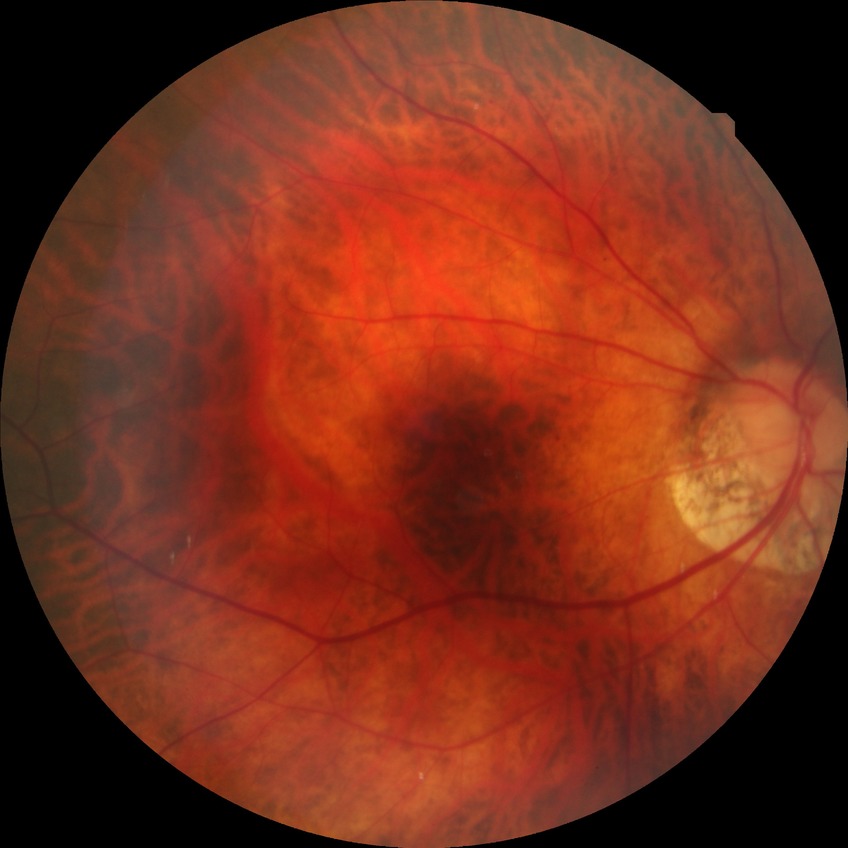 – Davis stage — NDR